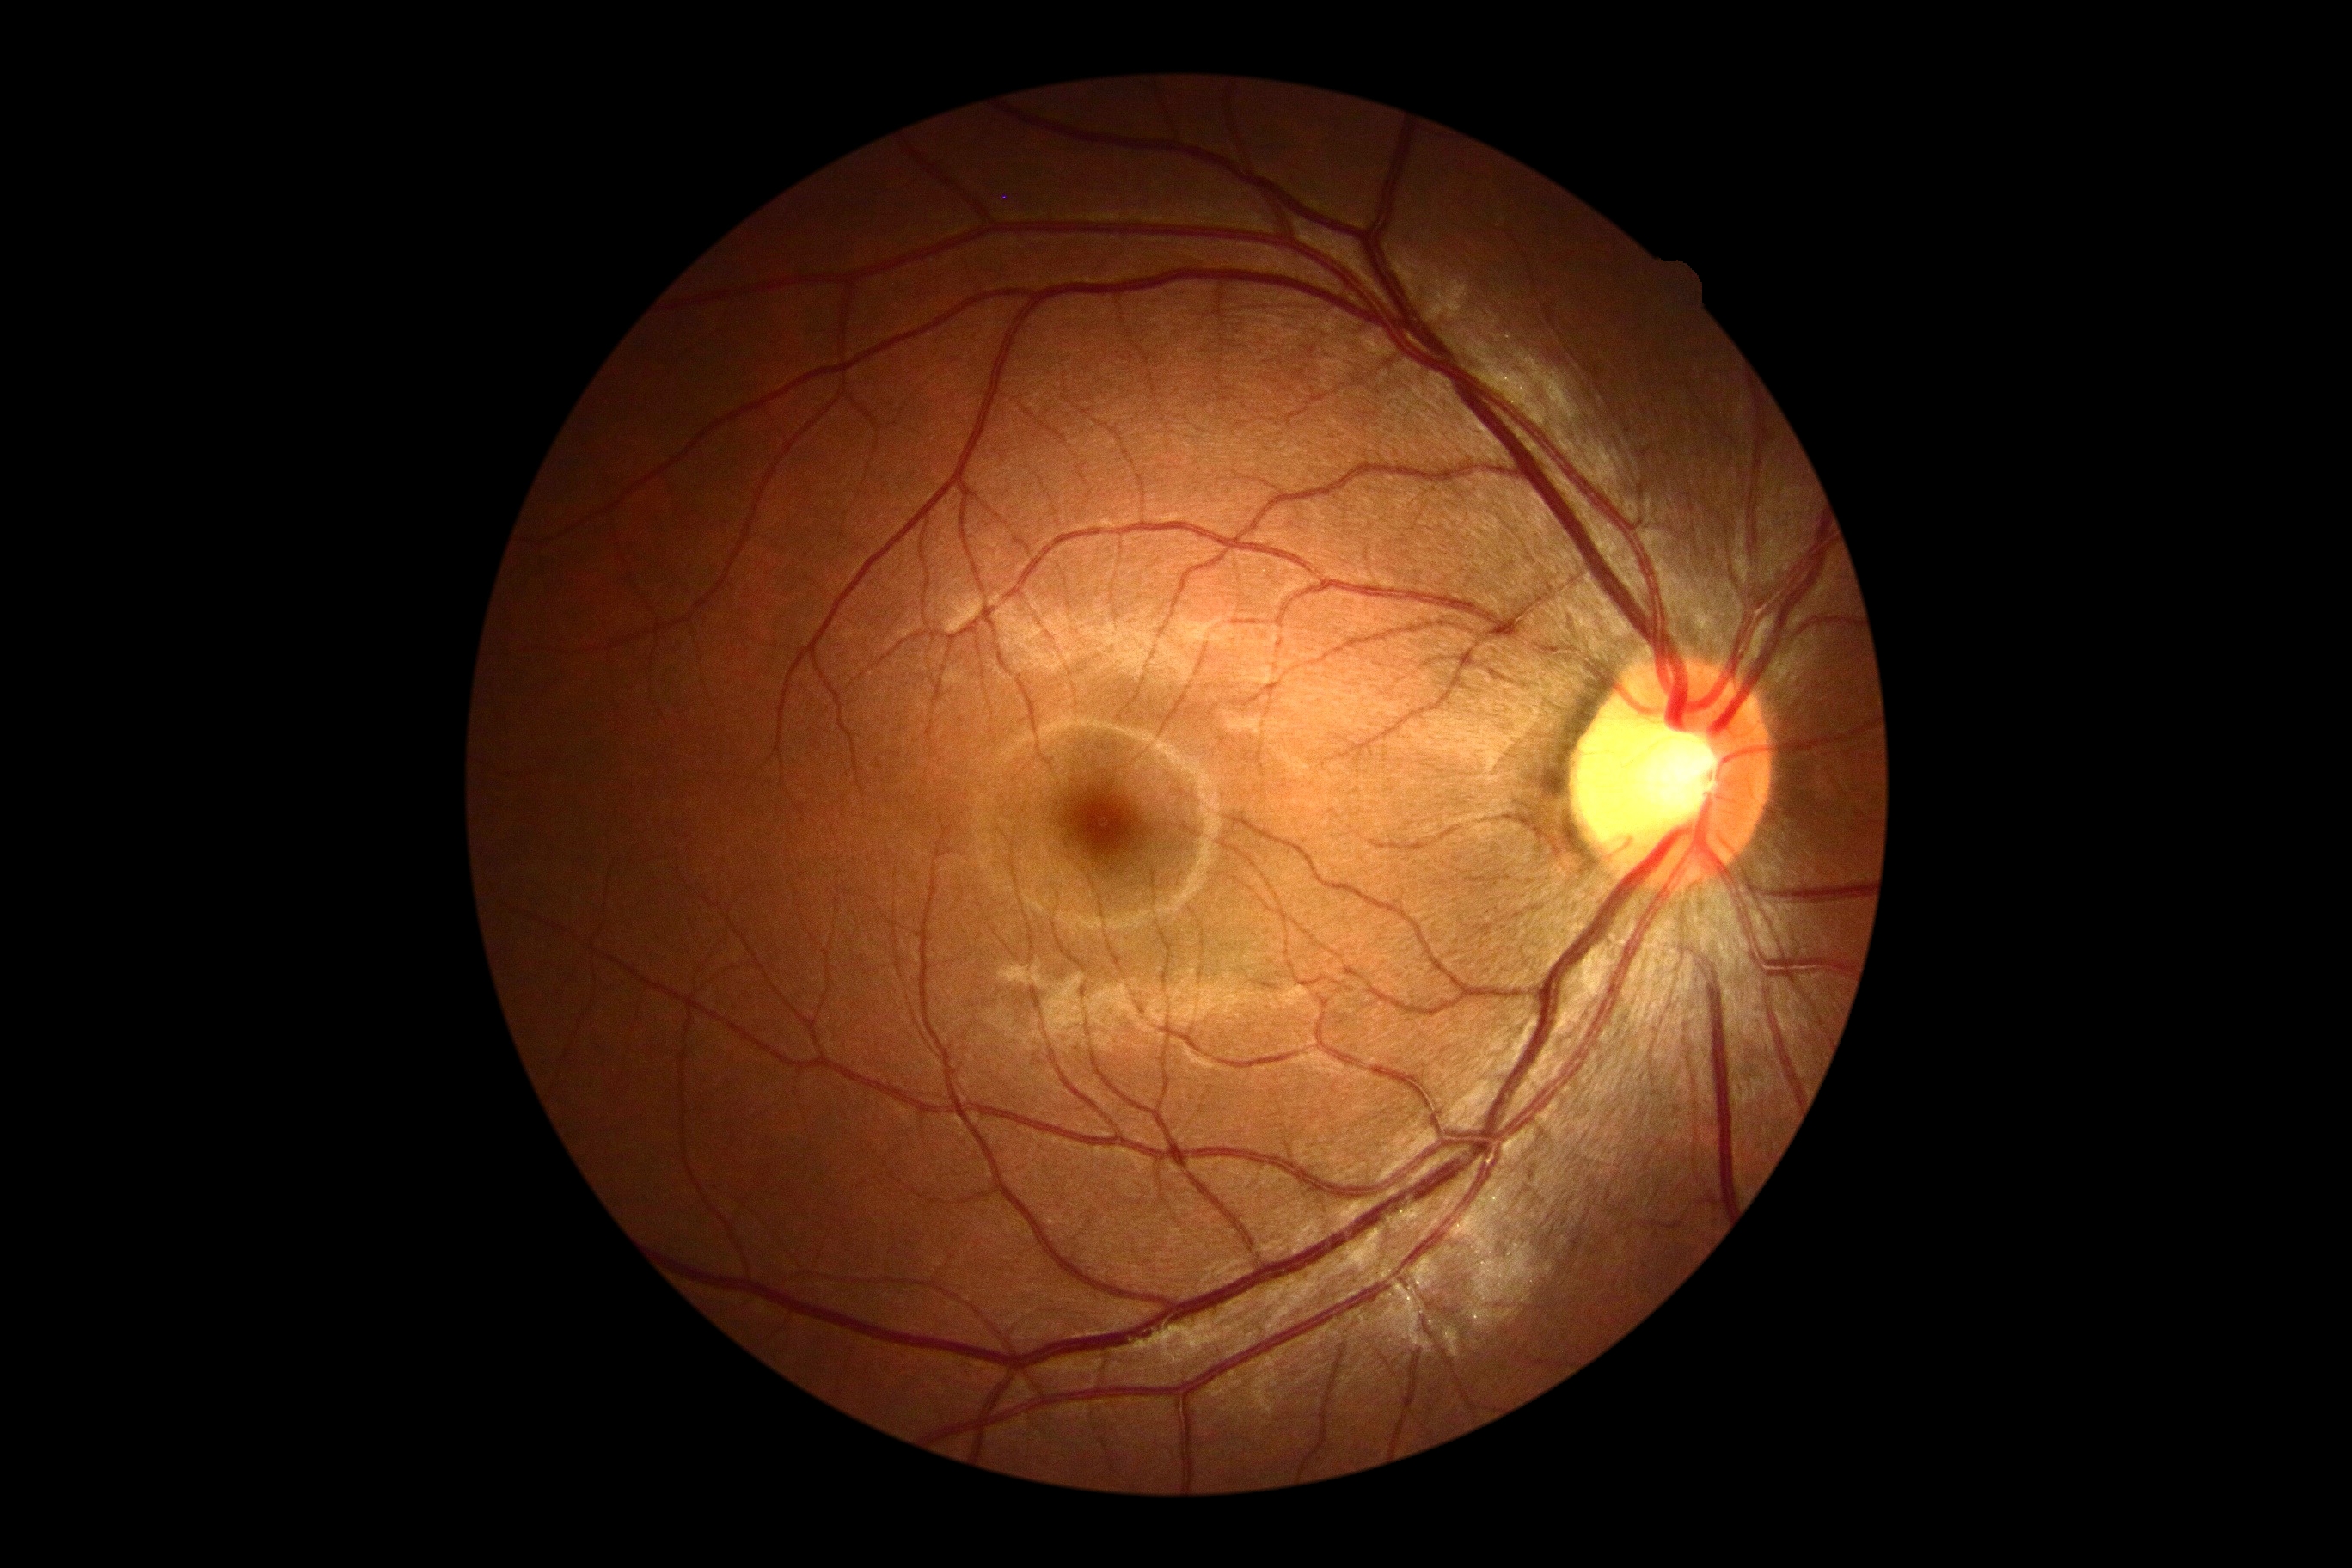
diabetic retinopathy (DR)=no apparent diabetic retinopathy (grade 0) — no visible signs of diabetic retinopathy.